Captured on a Topcon TRC-50DX fundus camera. Retinal fundus photograph — 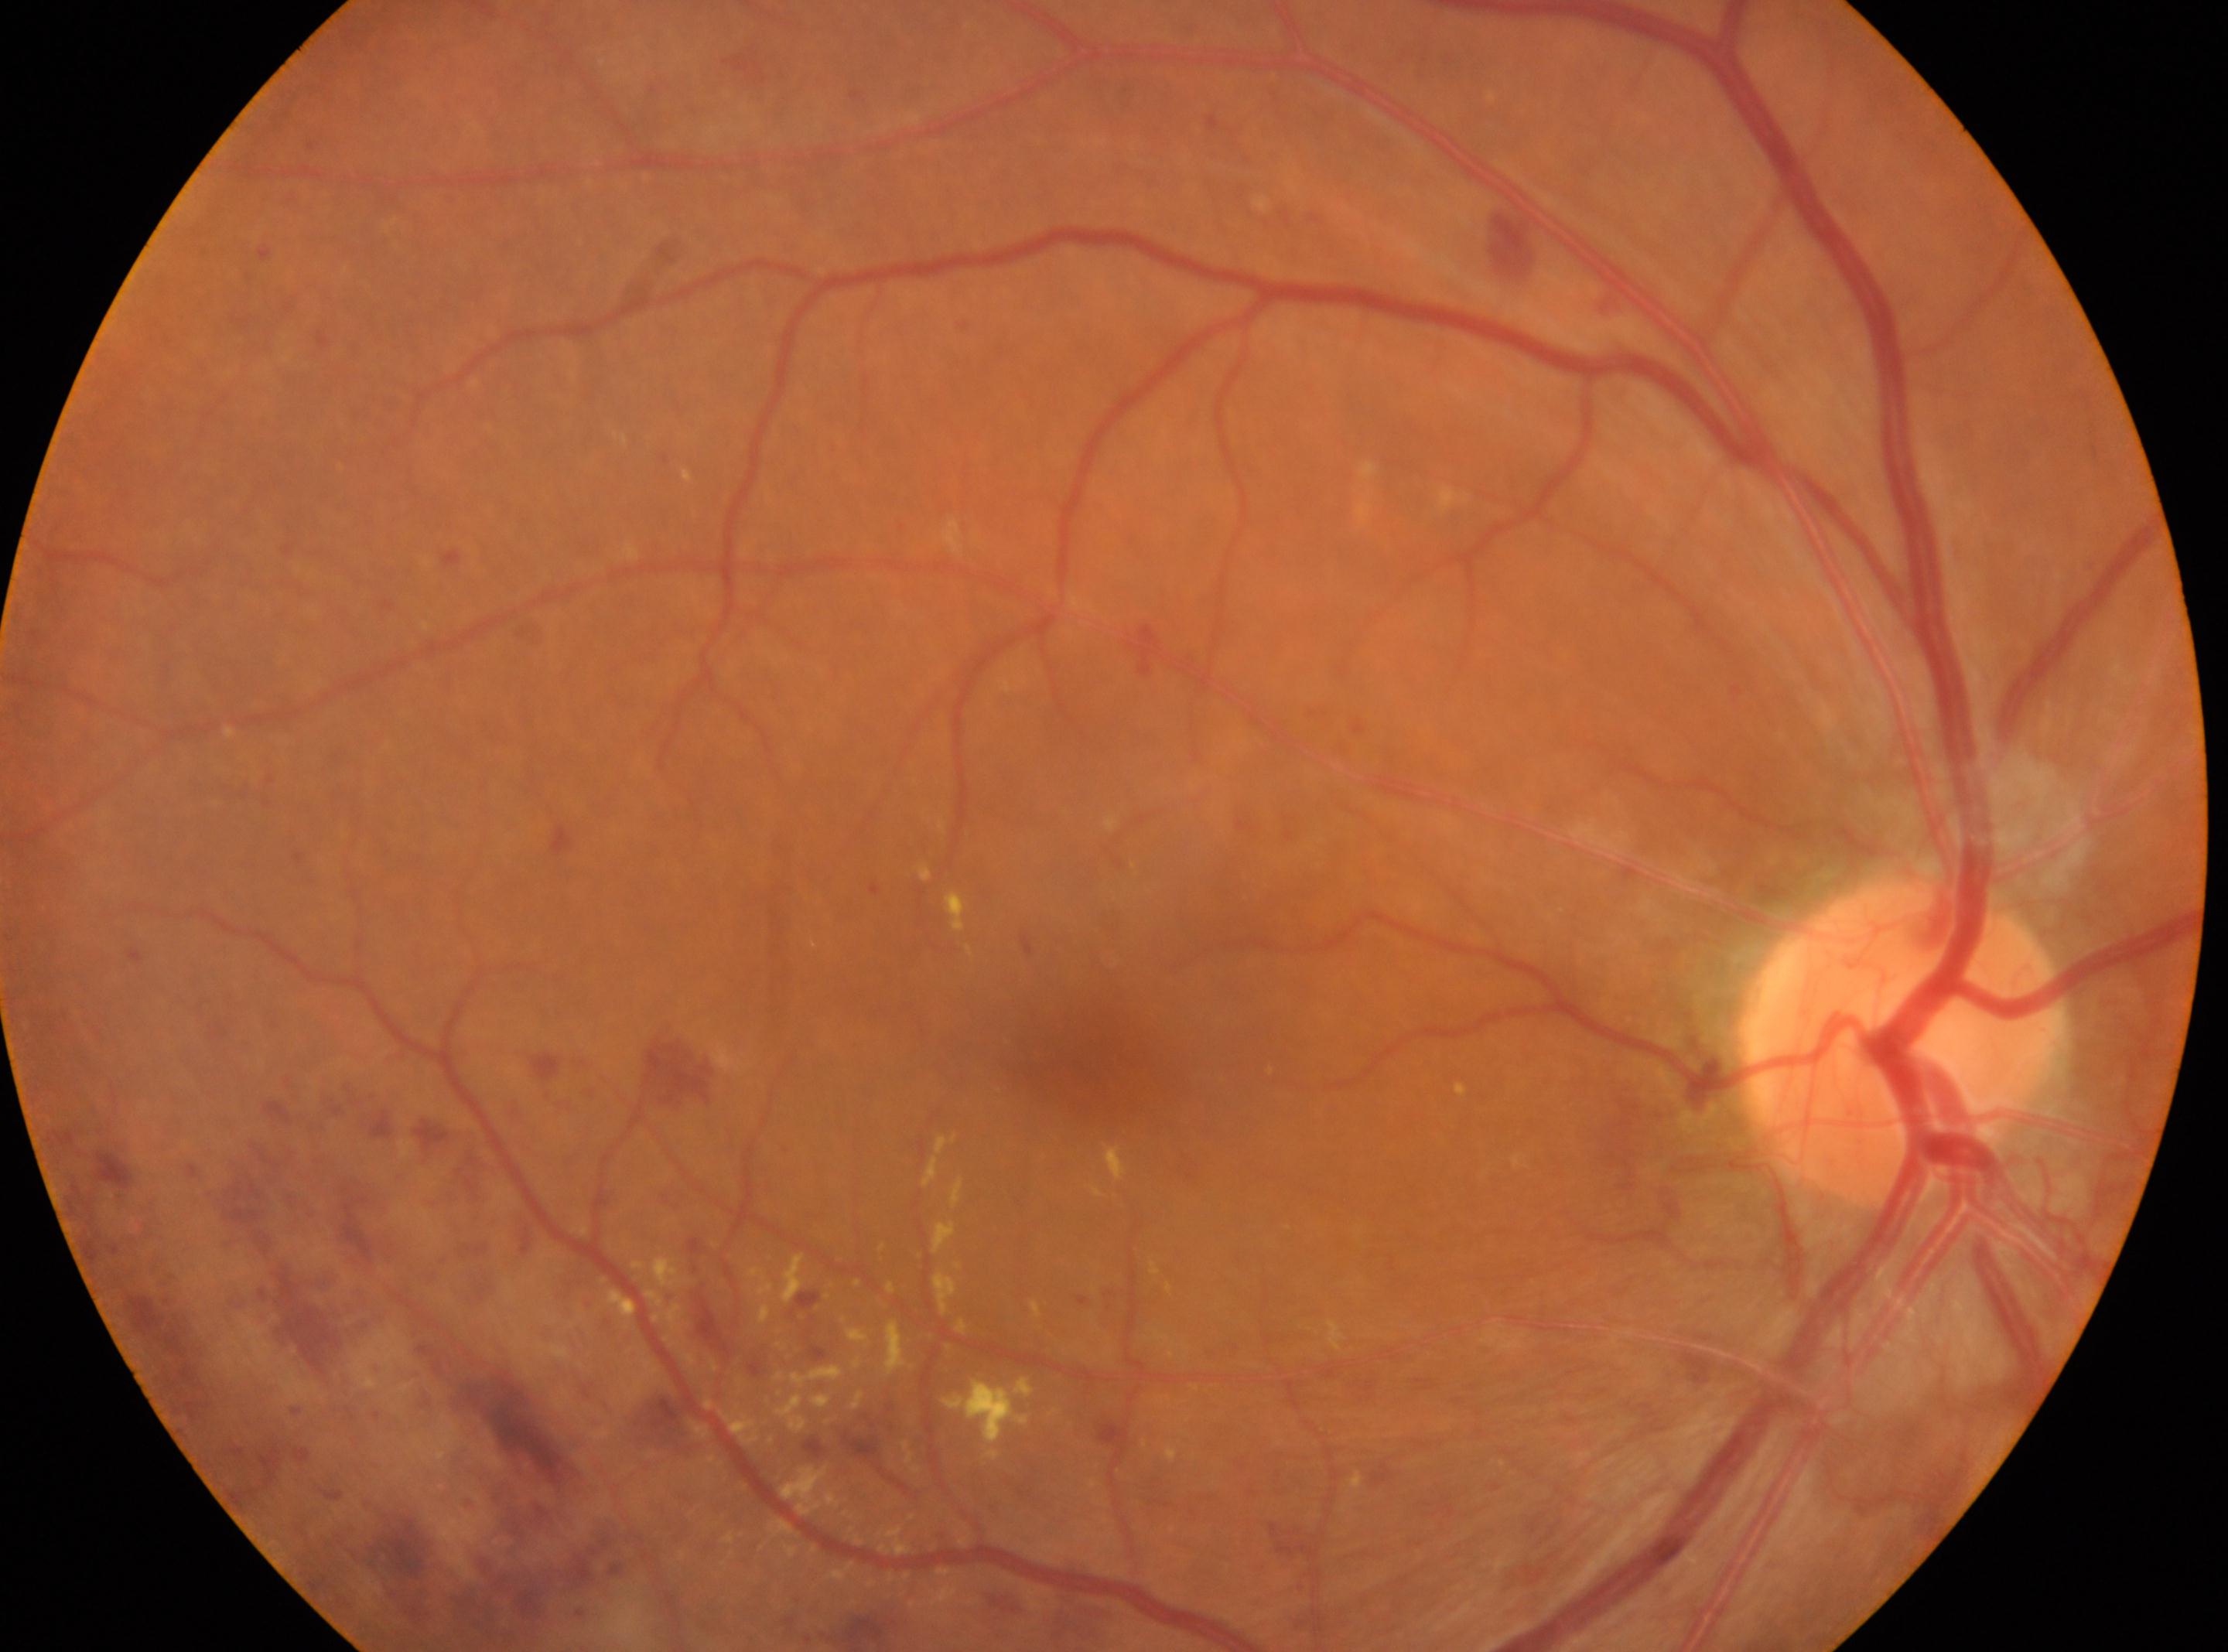 This is the right eye. The retinopathy is classified as proliferative diabetic retinopathy. Optic disk: x=1897, y=1041. Macular center located at x=1071, y=1038. Retinopathy grade: 4/4 — neovascularization and/or vitreous/pre-retinal hemorrhage.